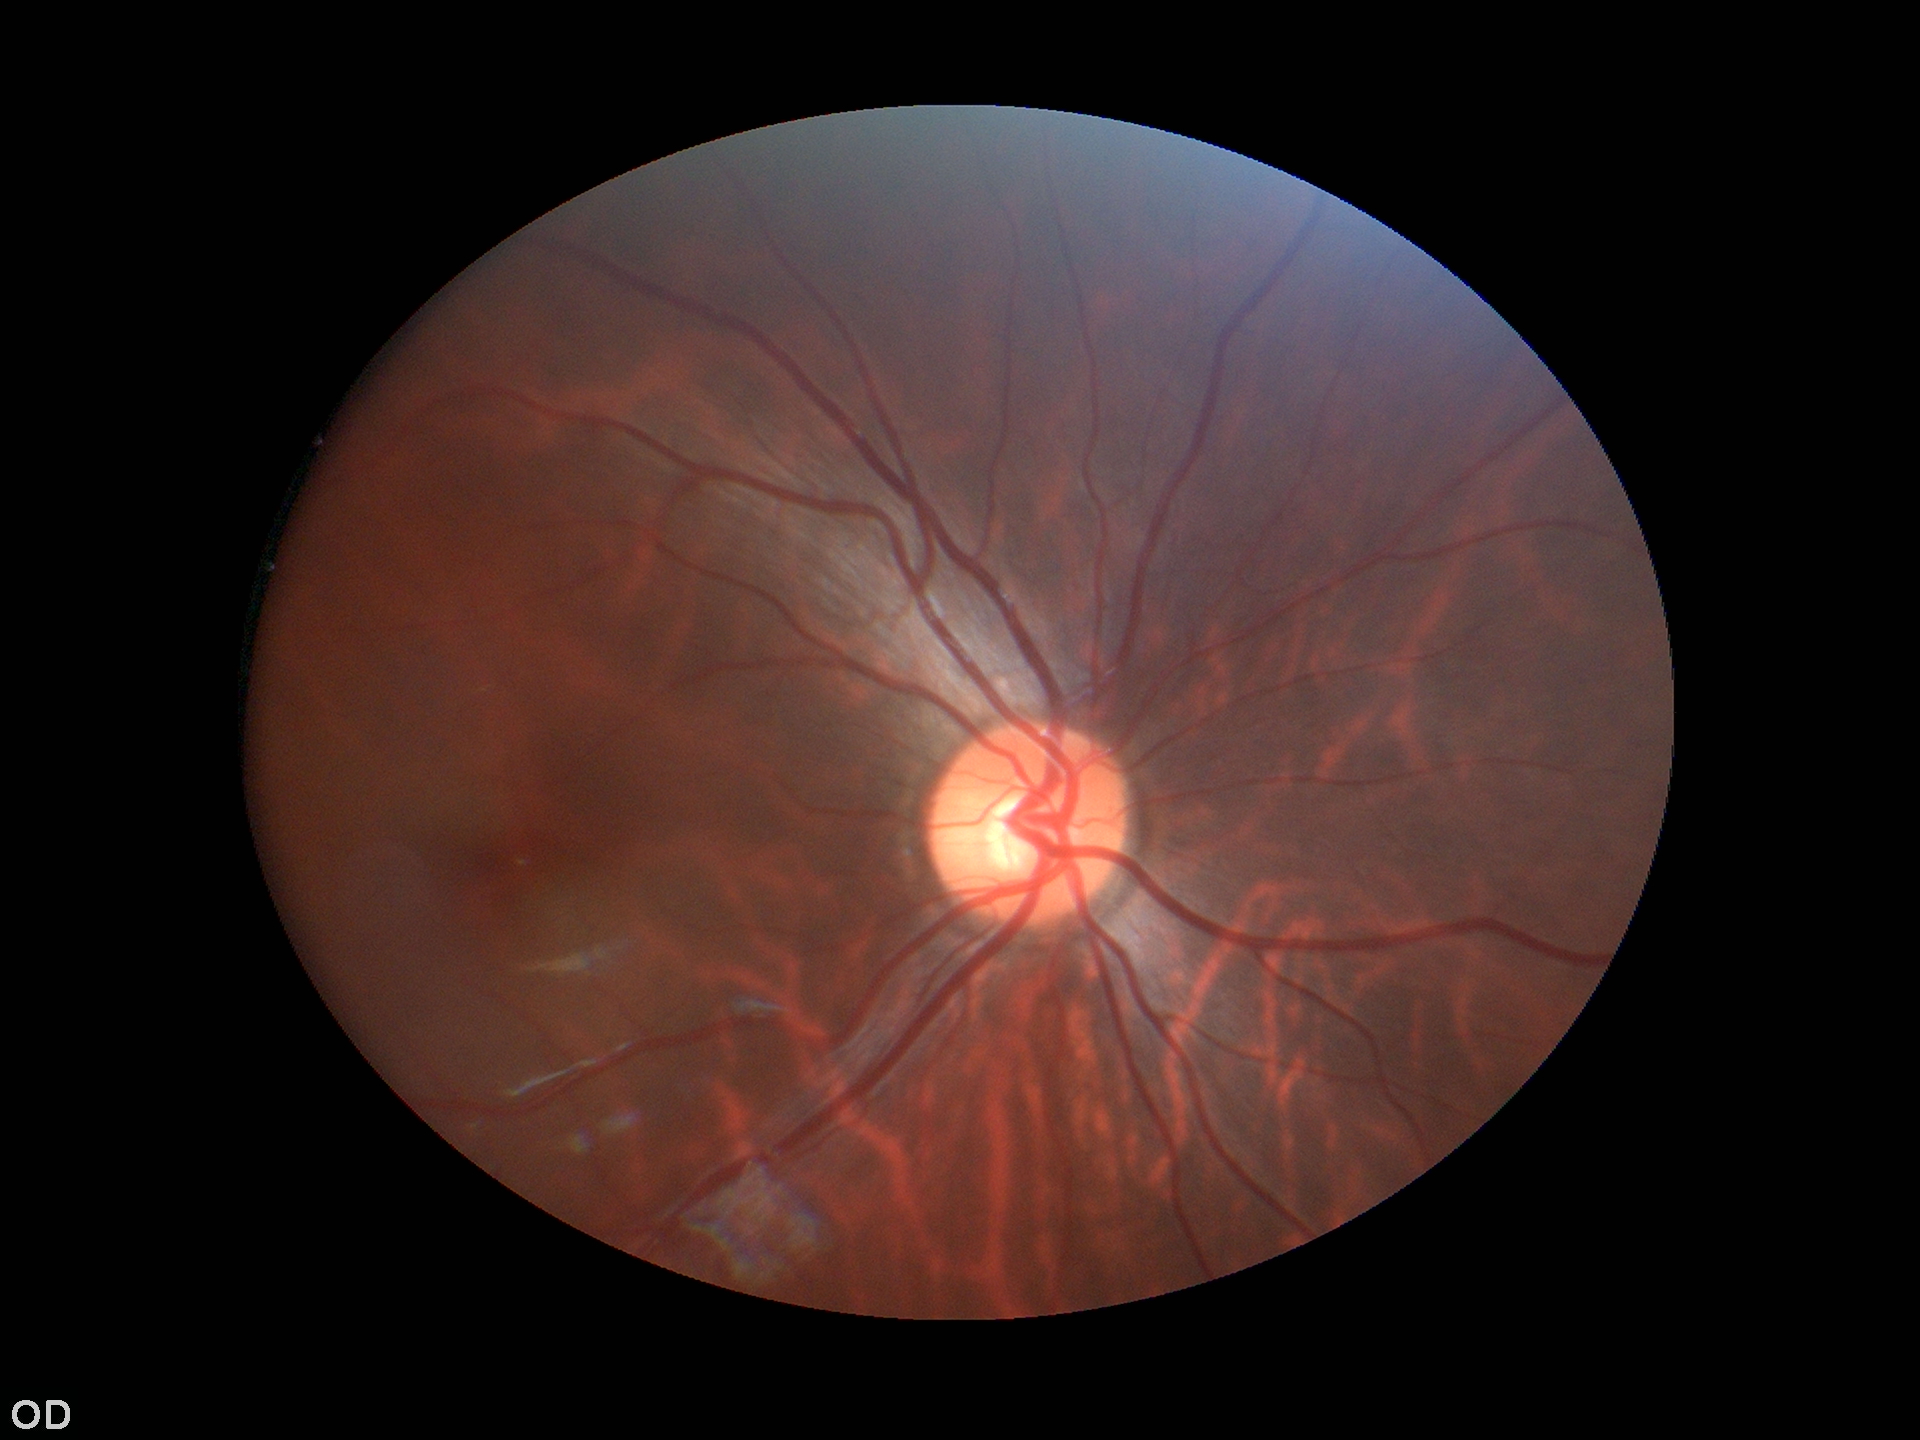 {"glaucoma_decision": "negative", "vcdr": "0.50"}